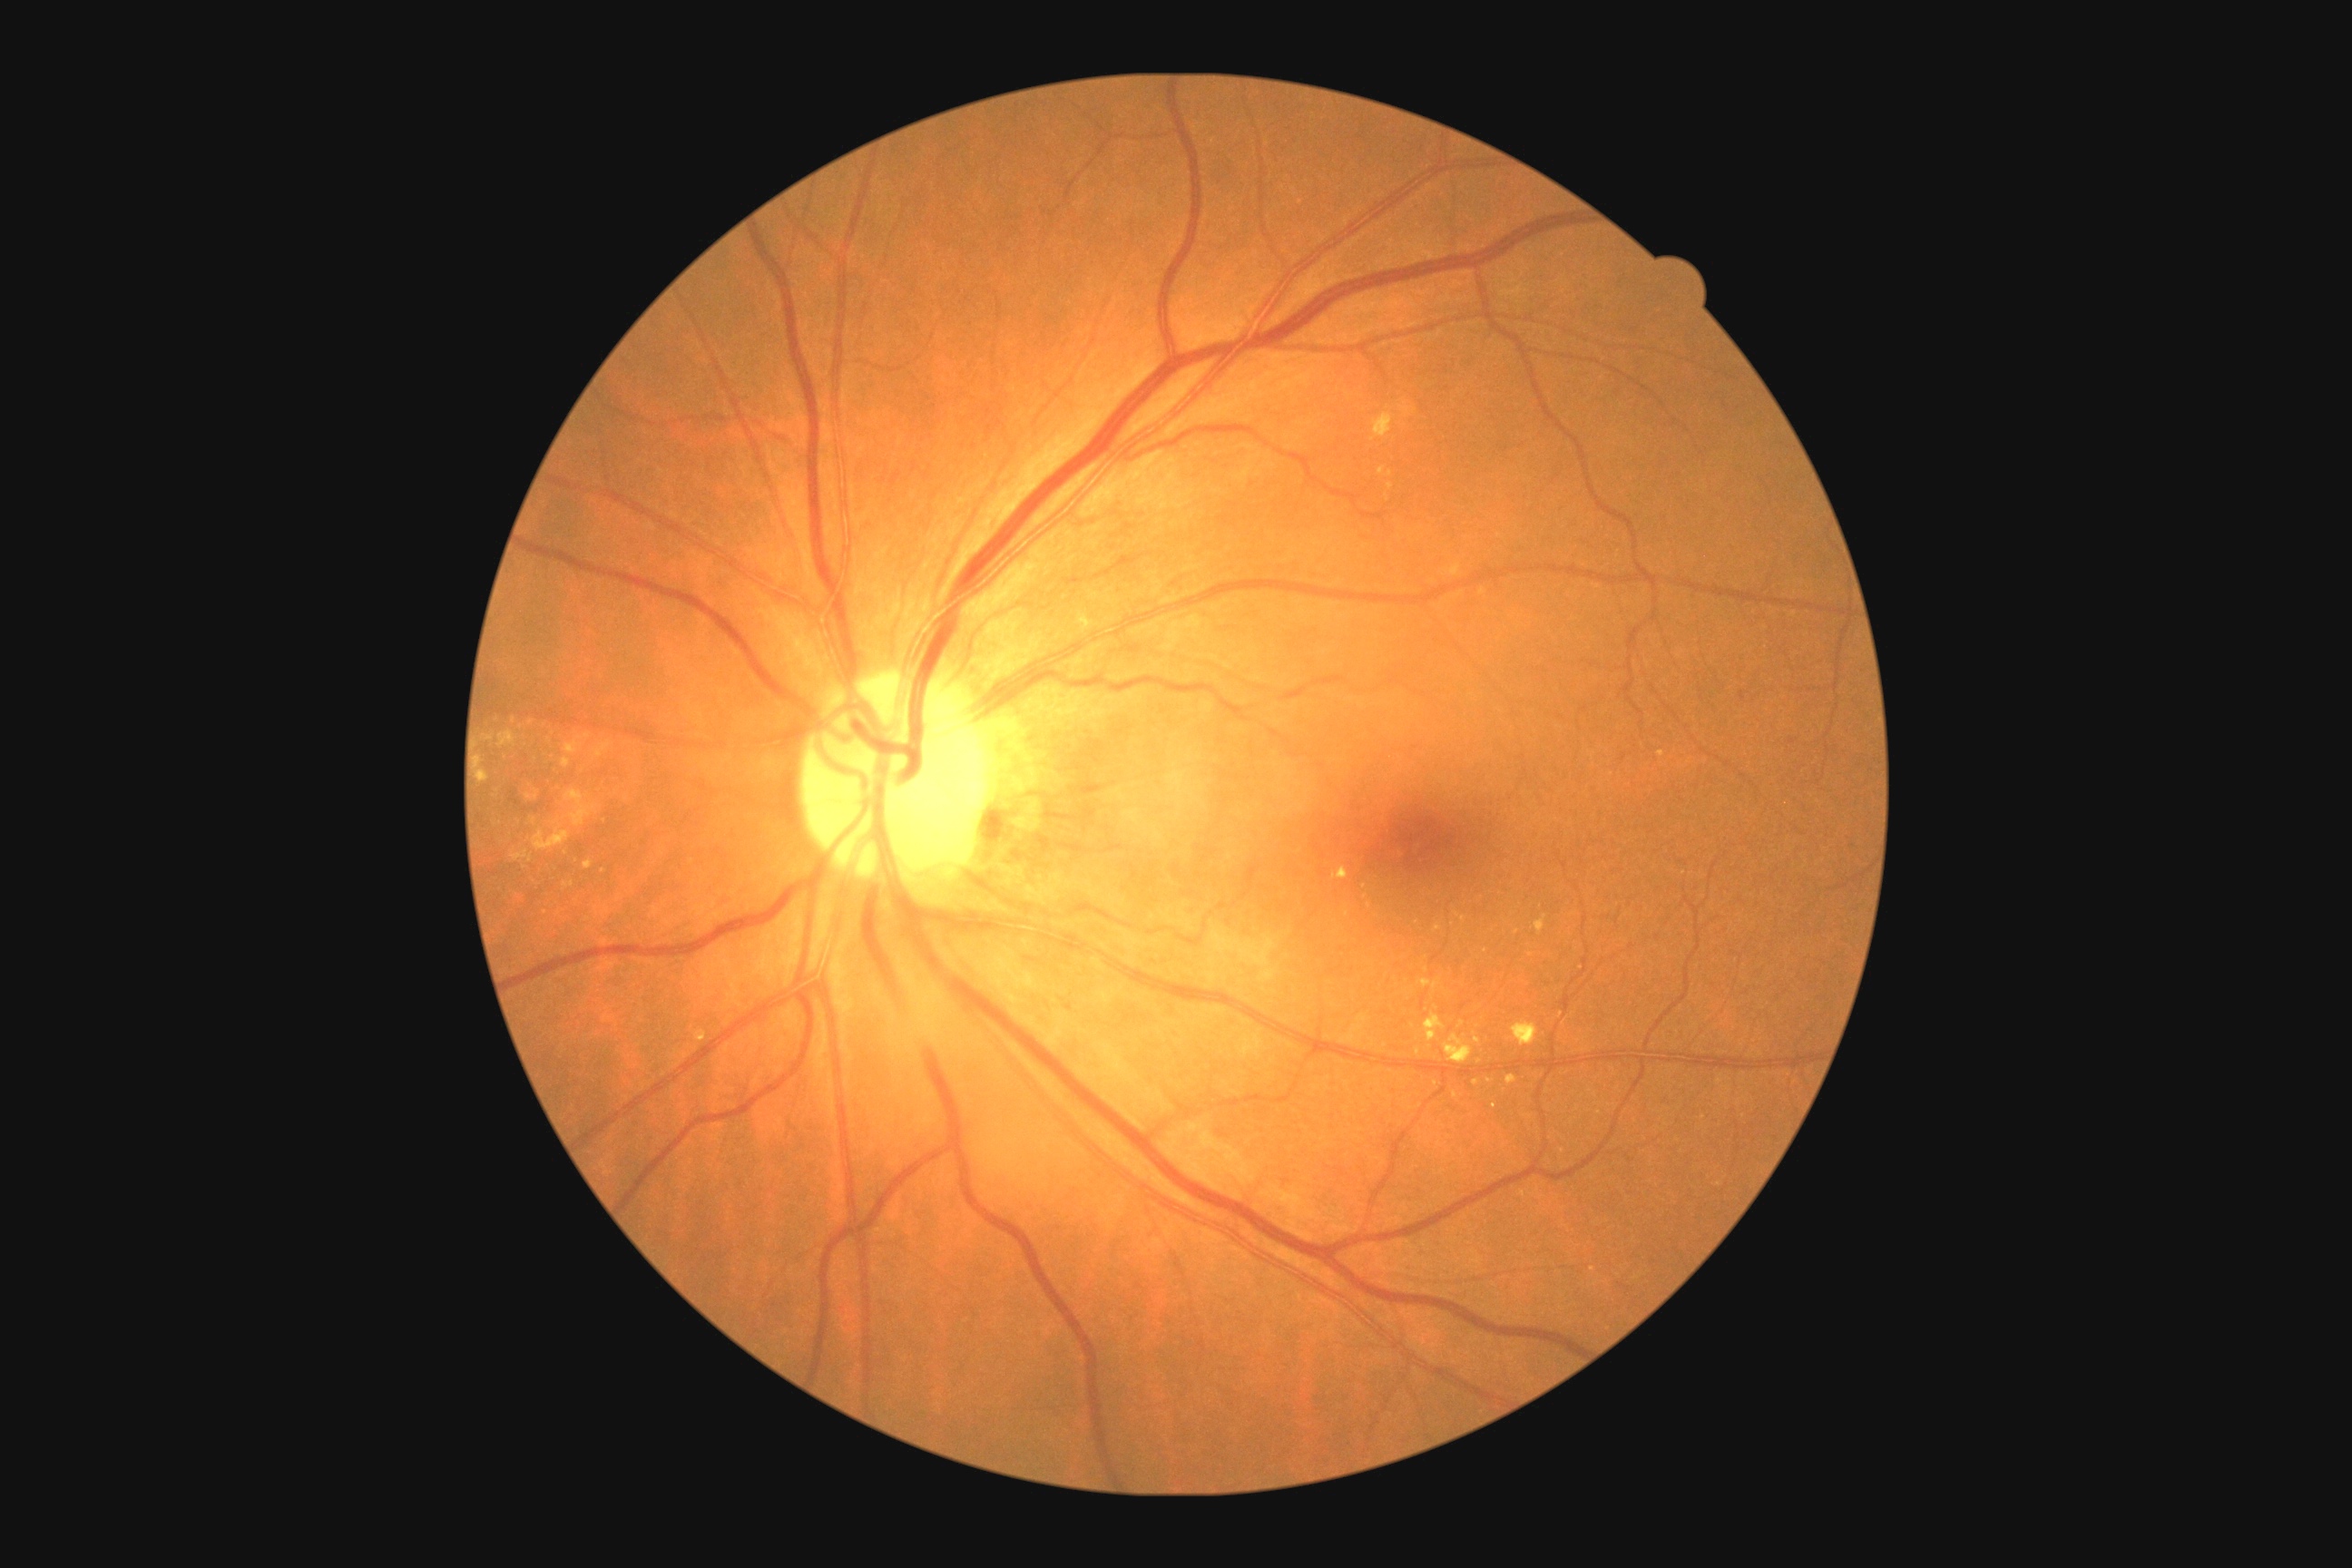 <lesions partial="true">
  <dr_grade>2</dr_grade>
  <ex partial="true">bbox=(1415, 1048, 1422, 1057), bbox=(1387, 484, 1395, 489), bbox=(696, 1030, 707, 1043), bbox=(511, 850, 533, 863), bbox=(533, 821, 571, 850), bbox=(583, 861, 594, 870), bbox=(1371, 413, 1393, 442), bbox=(594, 741, 612, 760), bbox=(1333, 867, 1349, 879)</ex>
  <ex_small_centers>{"x": 1478, "y": 1040}, {"x": 1490, "y": 1081}, {"x": 534, "y": 821}, {"x": 1365, "y": 897}, {"x": 1561, "y": 1014}, {"x": 1661, "y": 755}, {"x": 1413, "y": 1026}, {"x": 1463, "y": 919}, {"x": 604, "y": 872}</ex_small_centers>
</lesions>